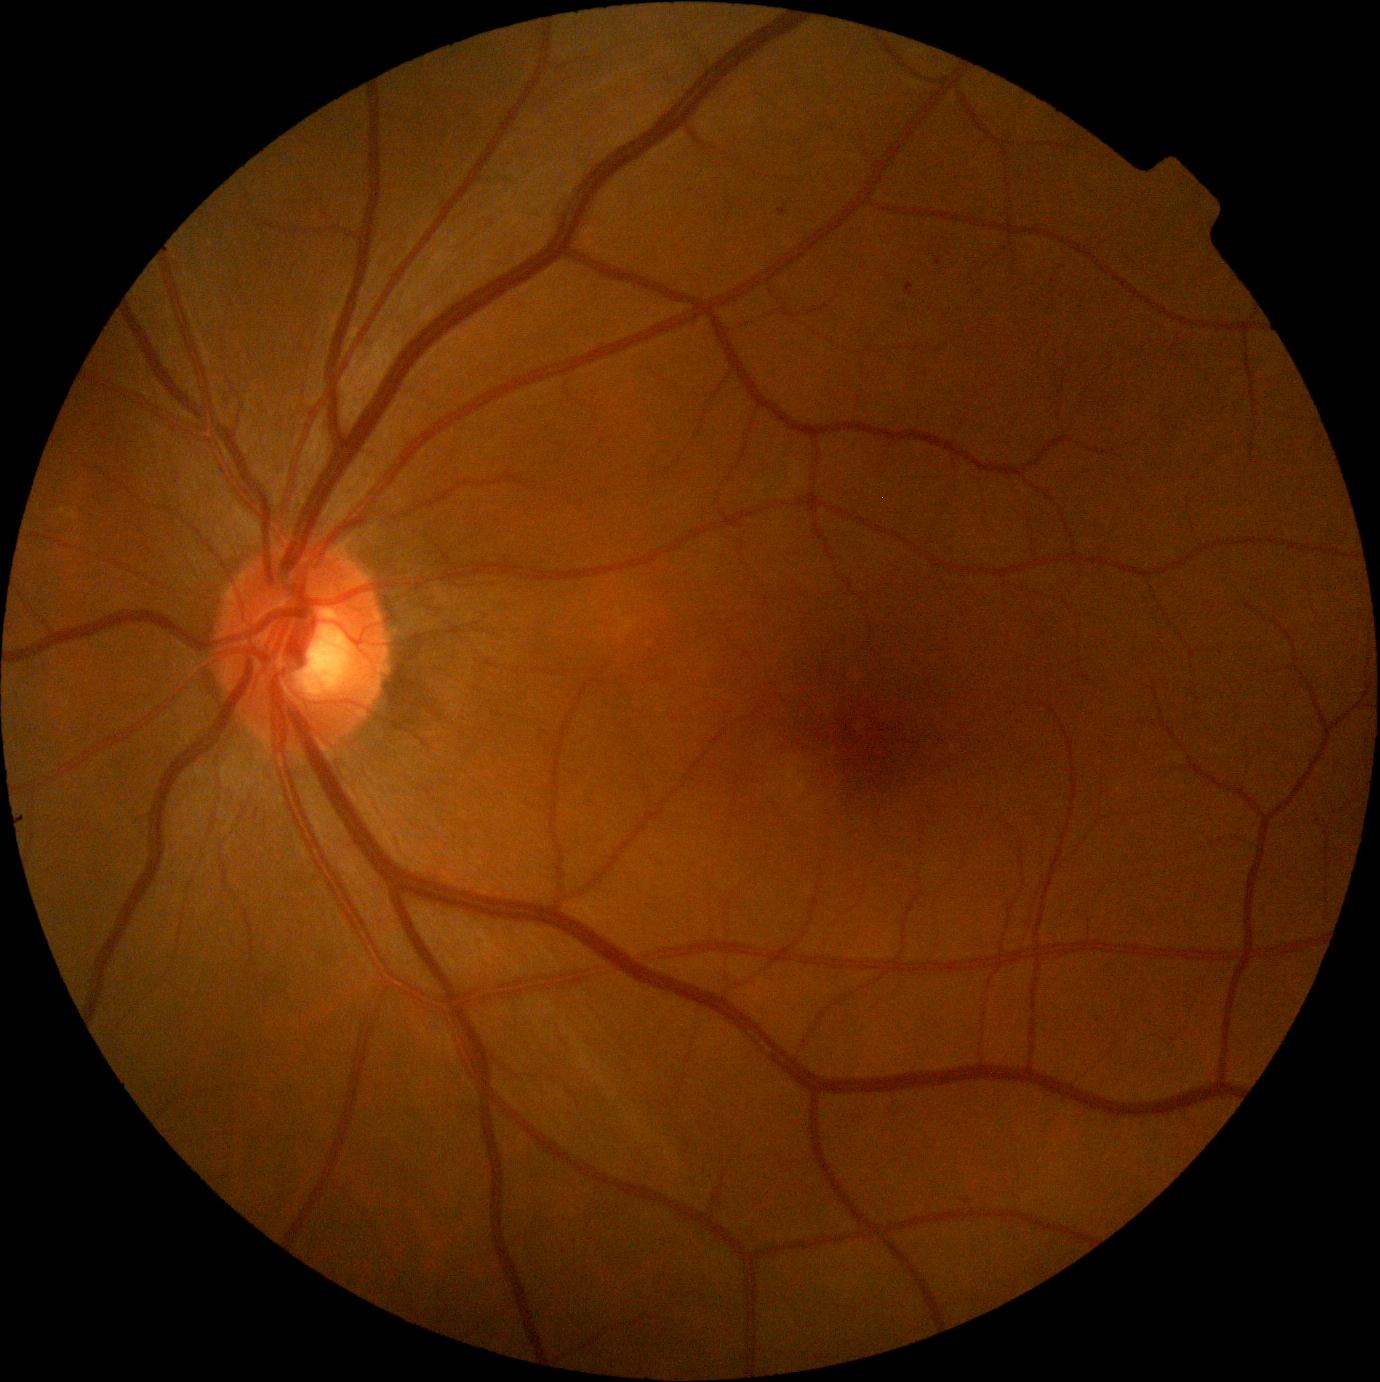
Retinopathy: grade 1 (mild NPDR) — presence of microaneurysms only.